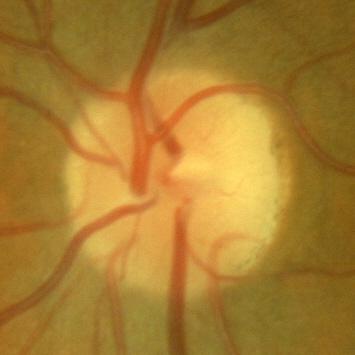
Finding: no signs of glaucoma.